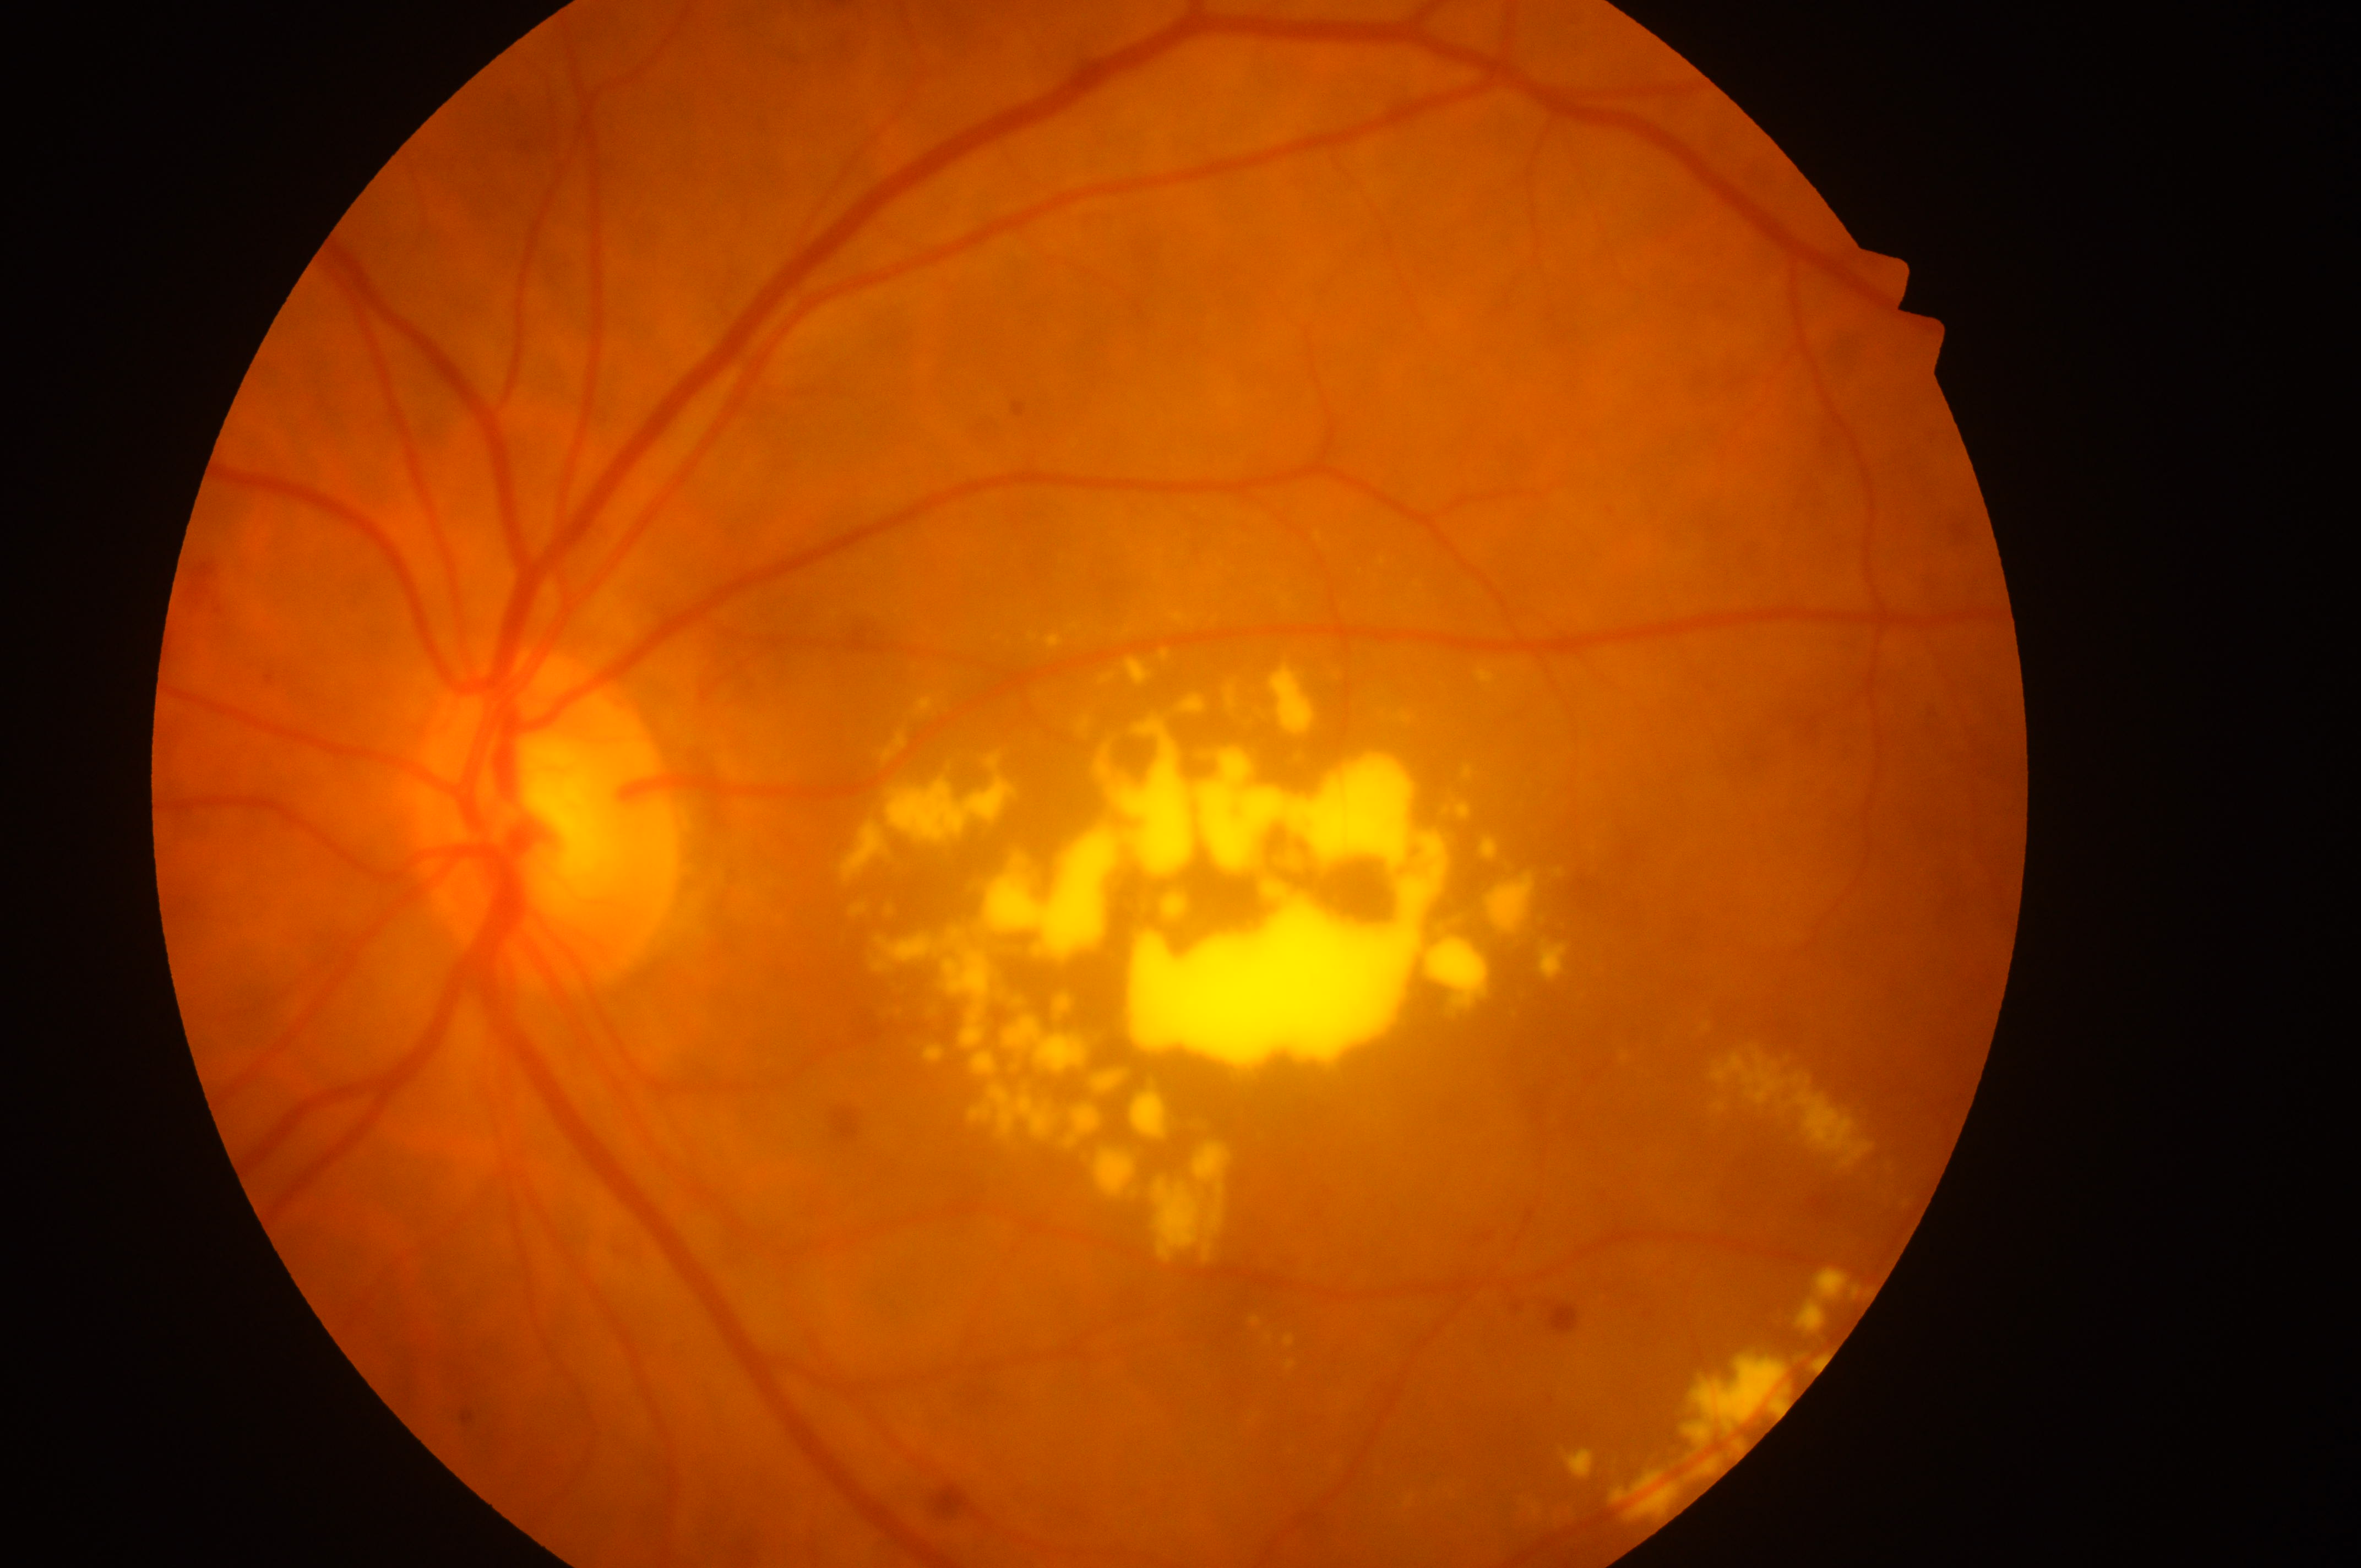

Fovea centralis: [1297, 961].
Macular edema: grade 2 (high risk).
The image shows the left eye.
Diabetic retinopathy severity is grade 2 (moderate NPDR).
The optic disk is at [546, 837].